1932x1932. Retinal fundus photograph. FOV: 45 degrees — 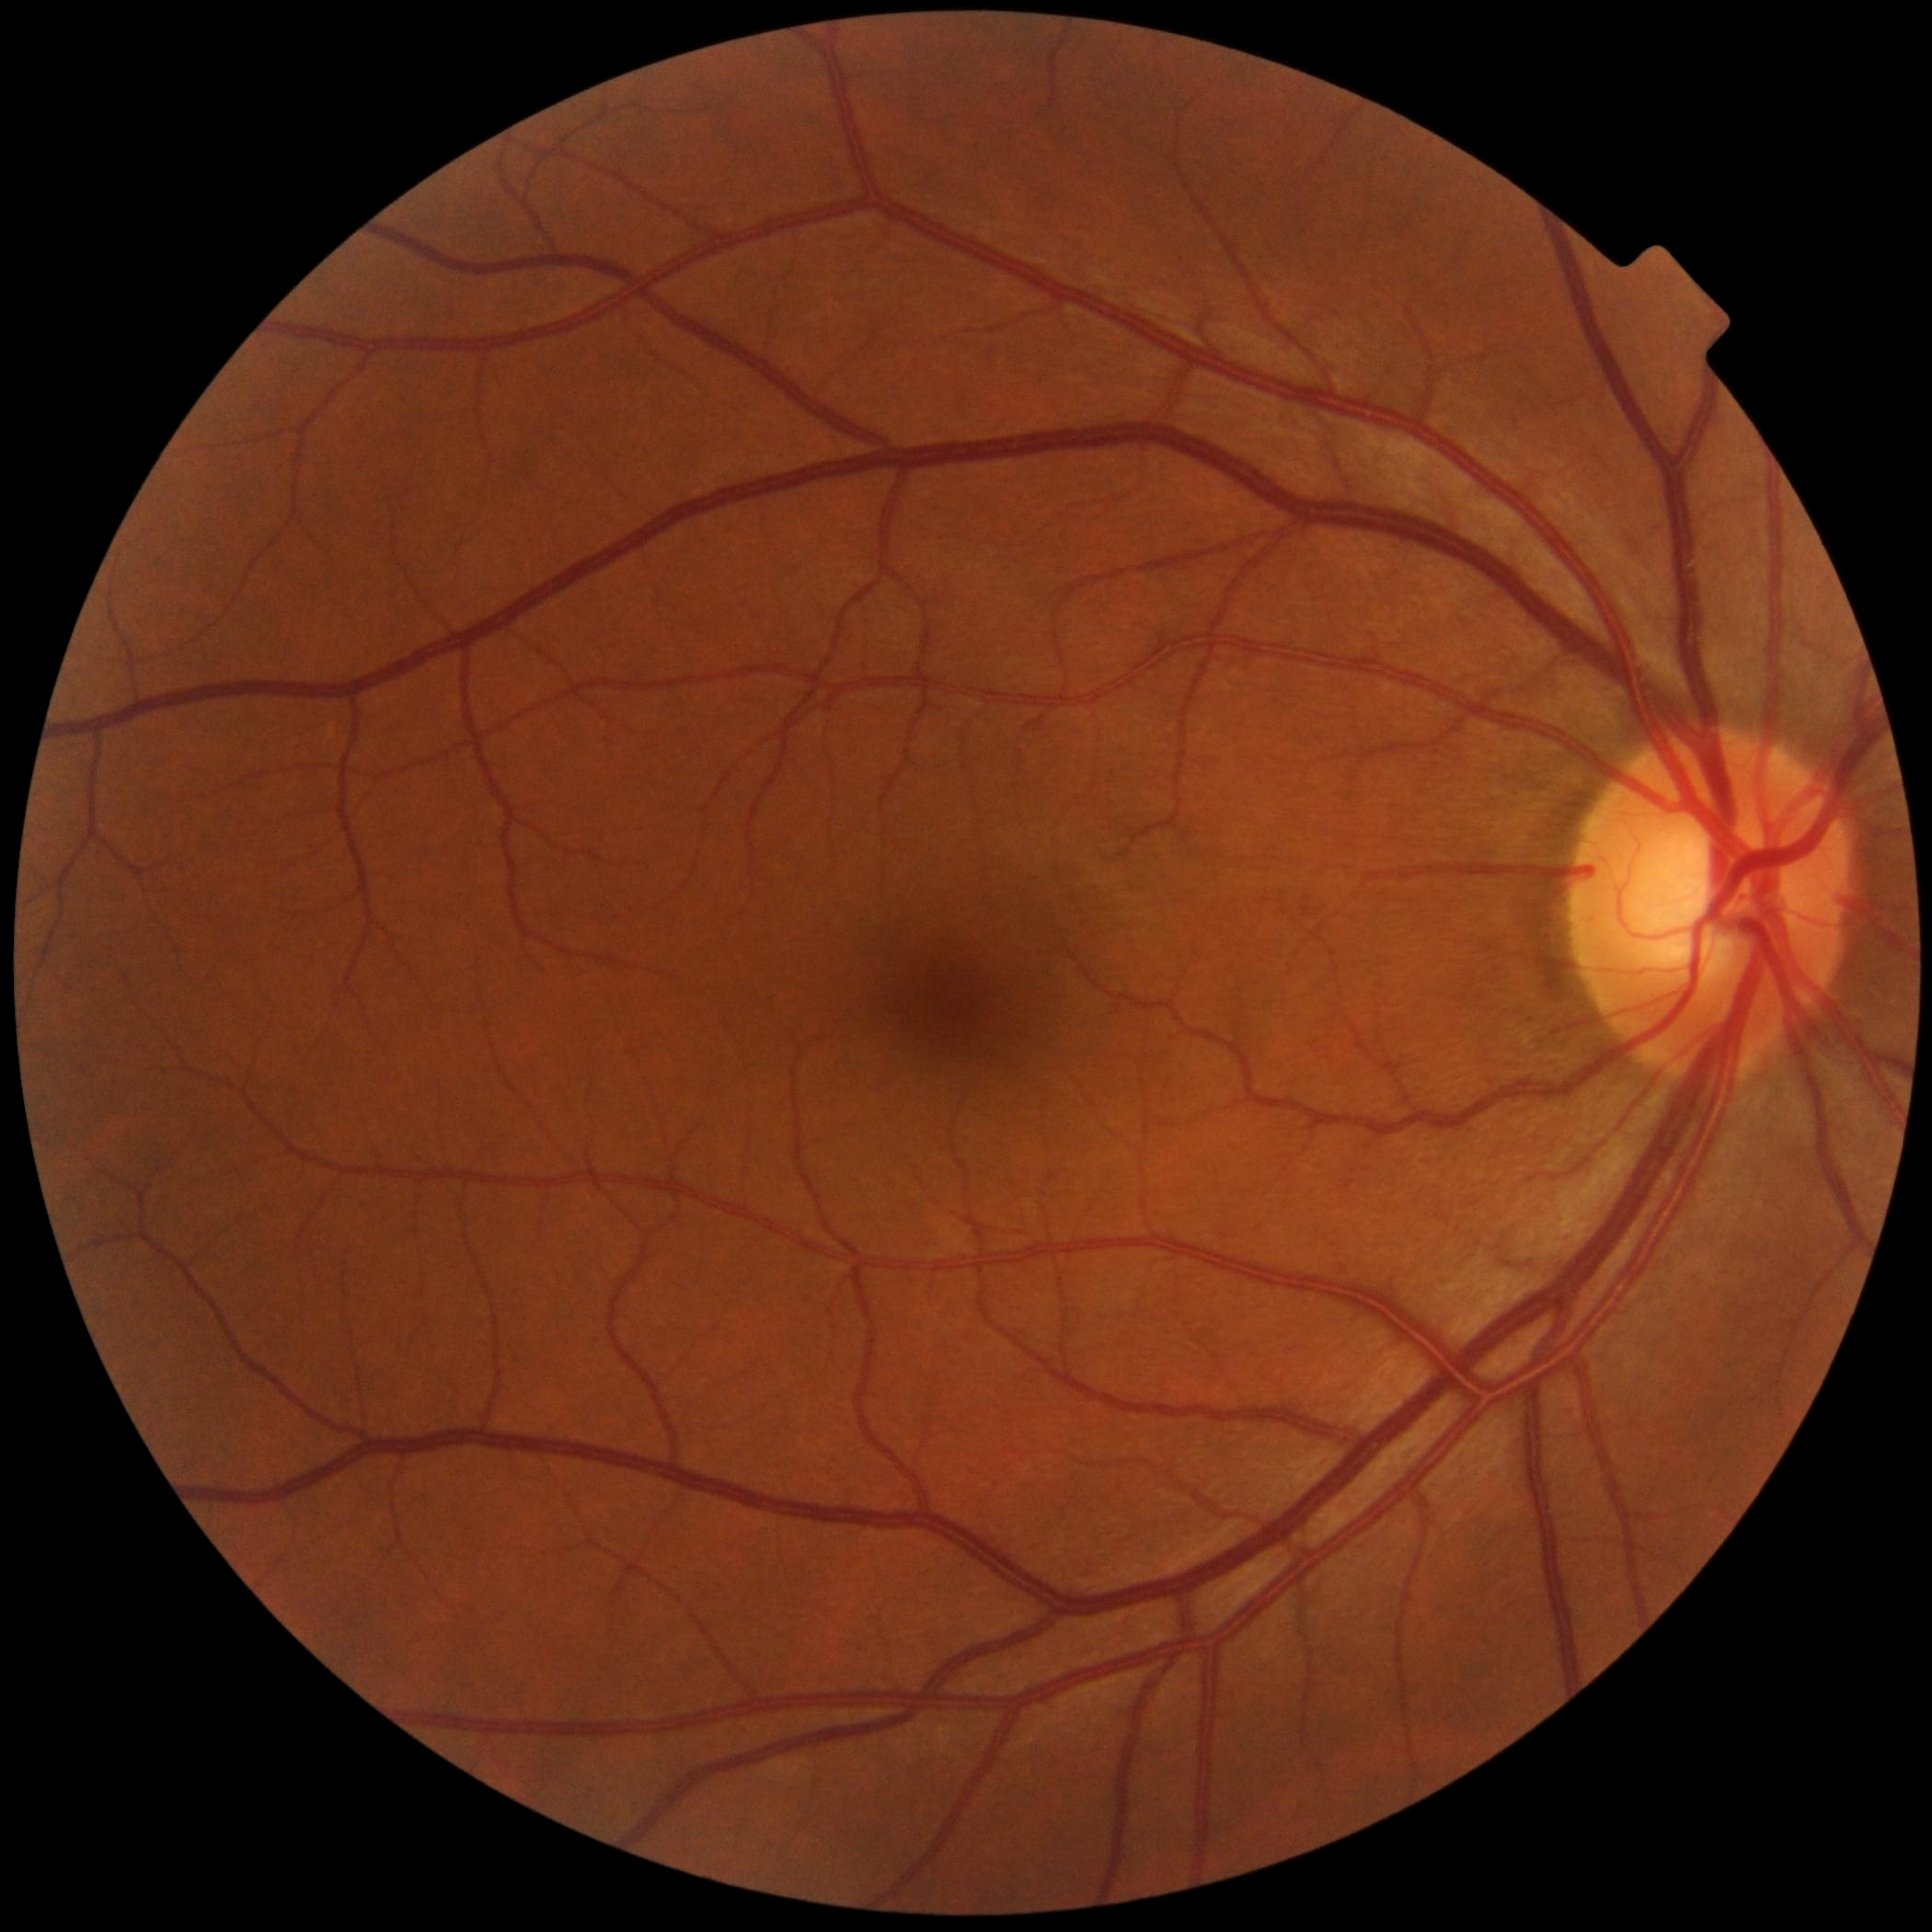
Retinopathy grade is 0.